1924x1556, 50-degree field of view, color fundus image:
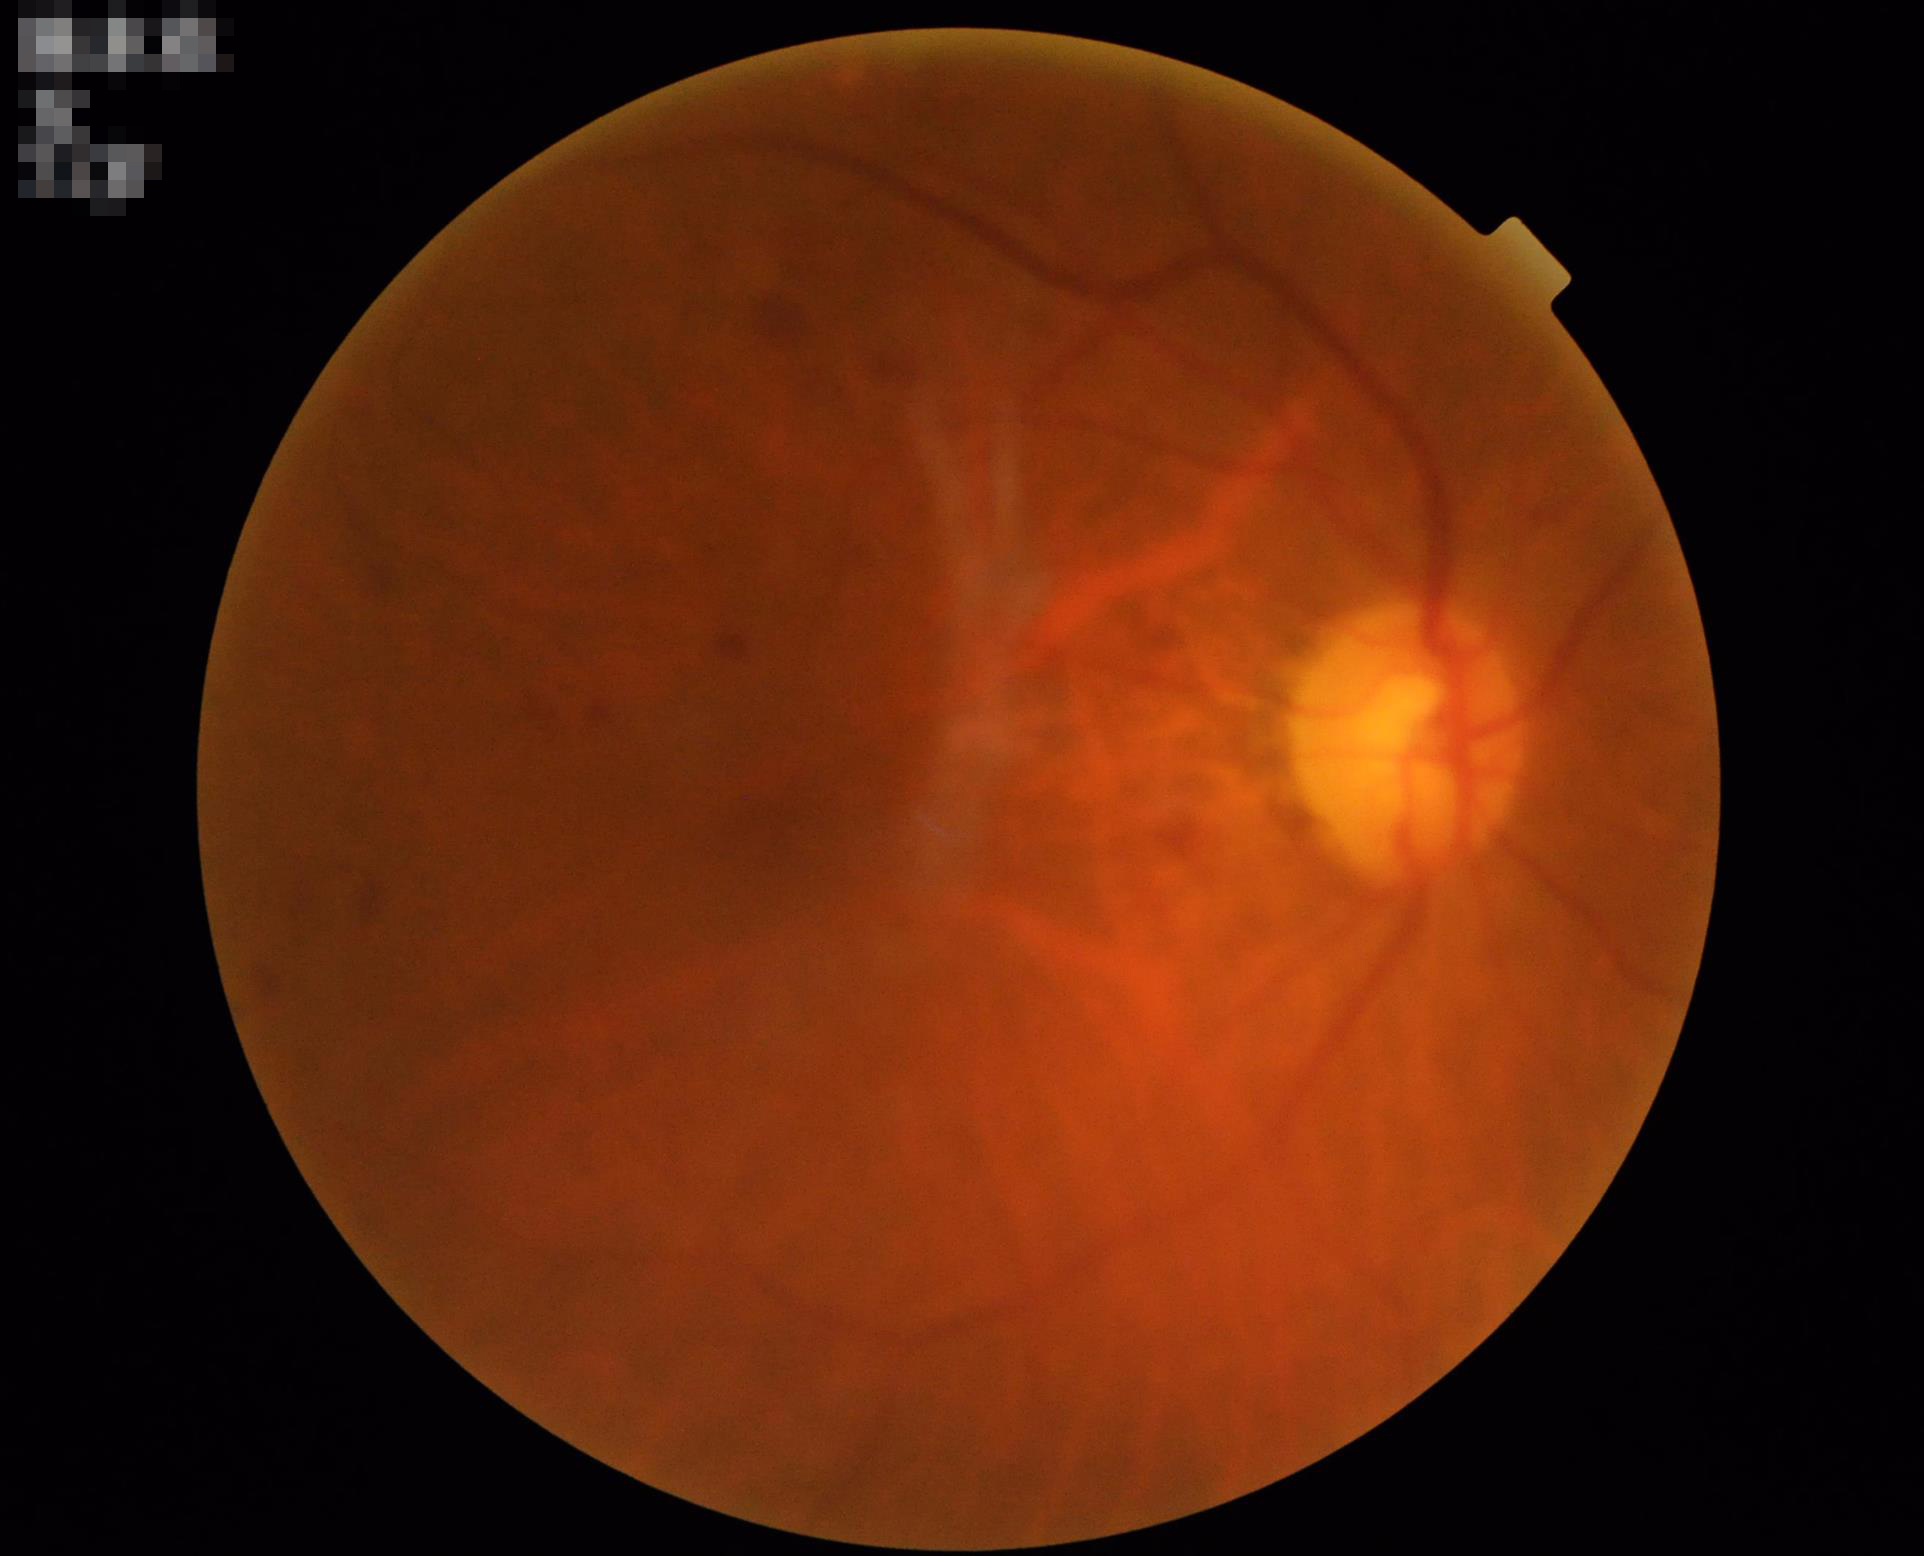
Overall image quality is good. Out of focus; structures are indistinct. Vessels and details are hard to distinguish.